CFP
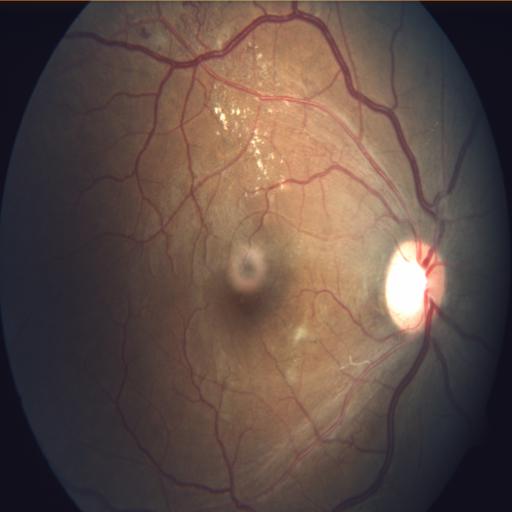

Abnormalities (2): vasculitis | optic disc cupping.